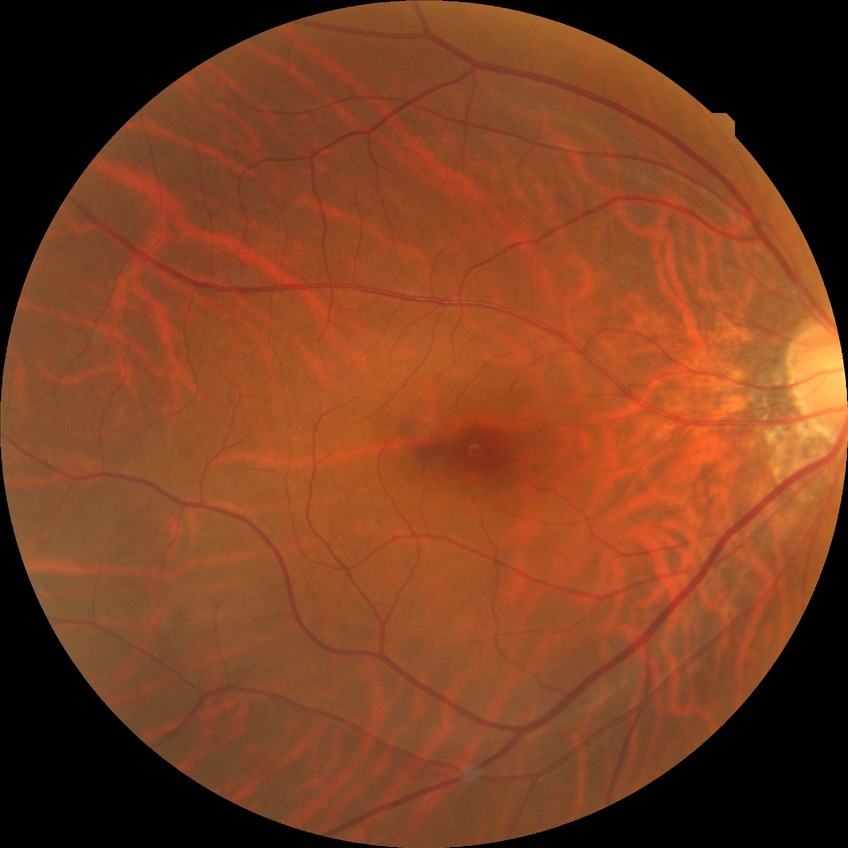
Diabetic retinopathy stage: no diabetic retinopathy.